45° field of view. 1380x1382. Color fundus photograph — 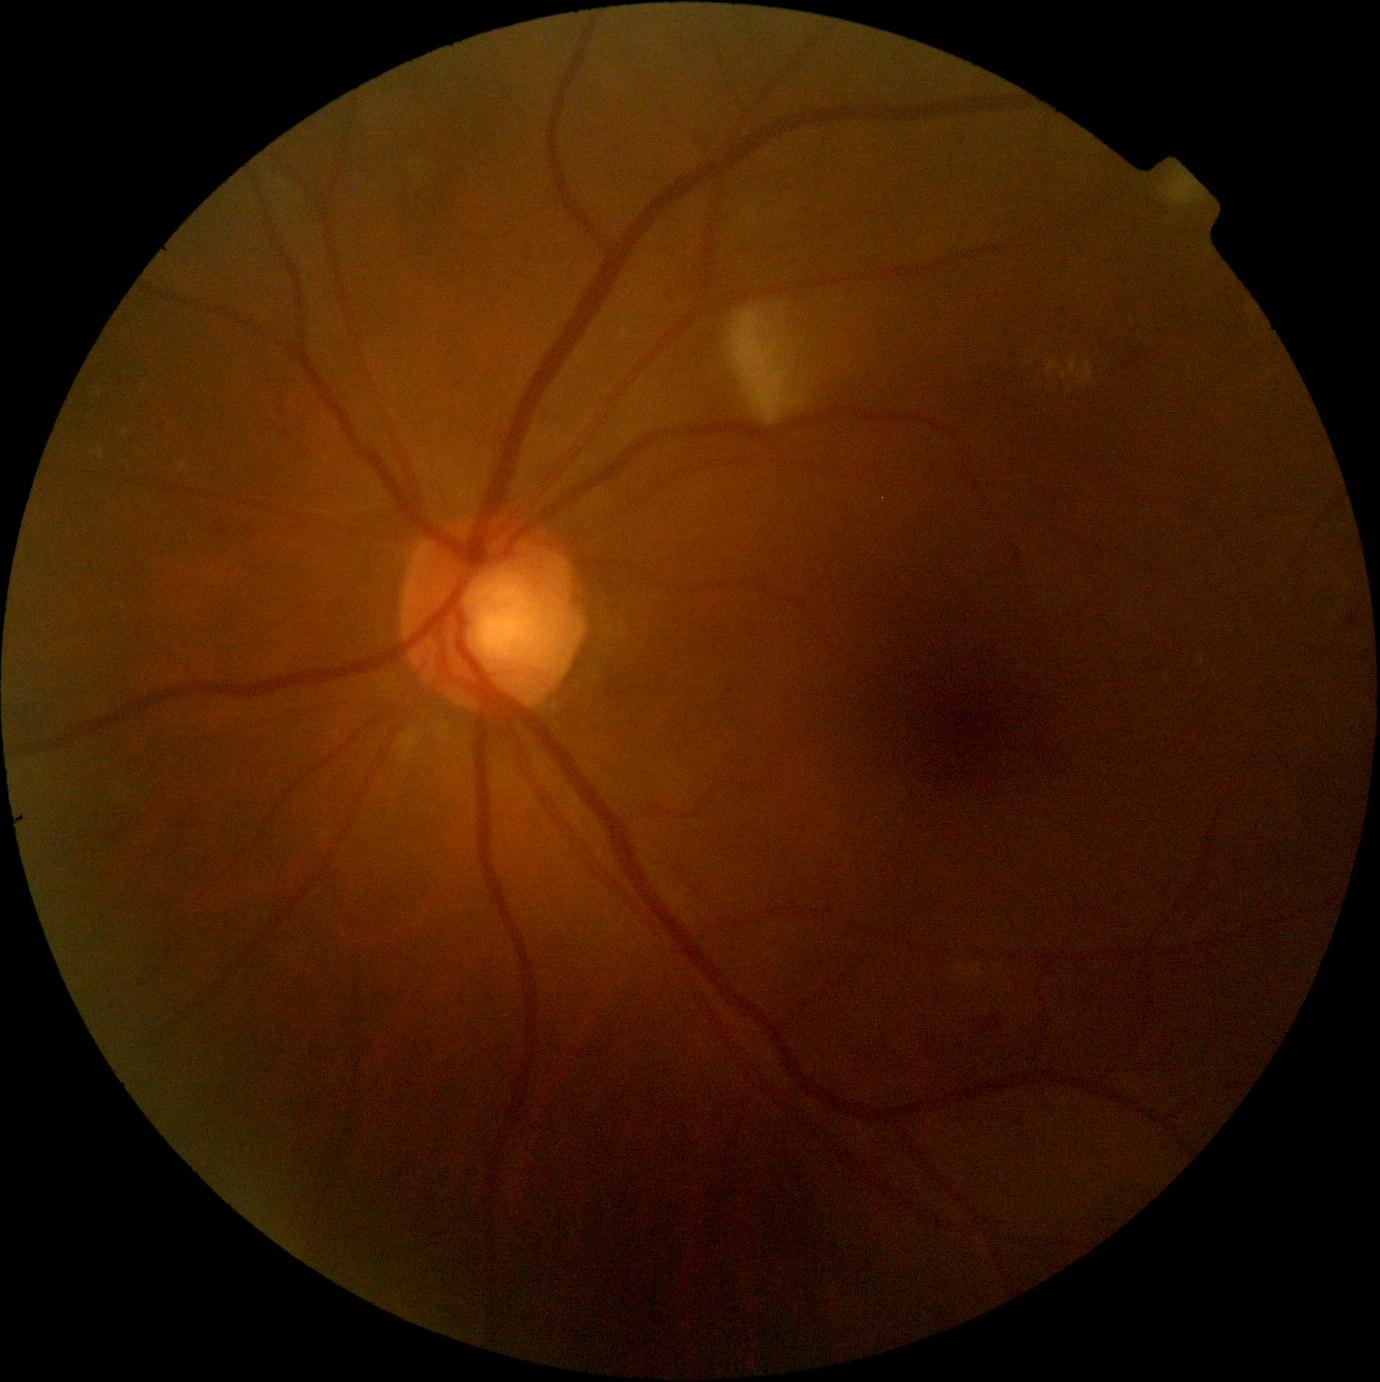
  dr_category: non-proliferative diabetic retinopathy
  dr_grade: 2/4